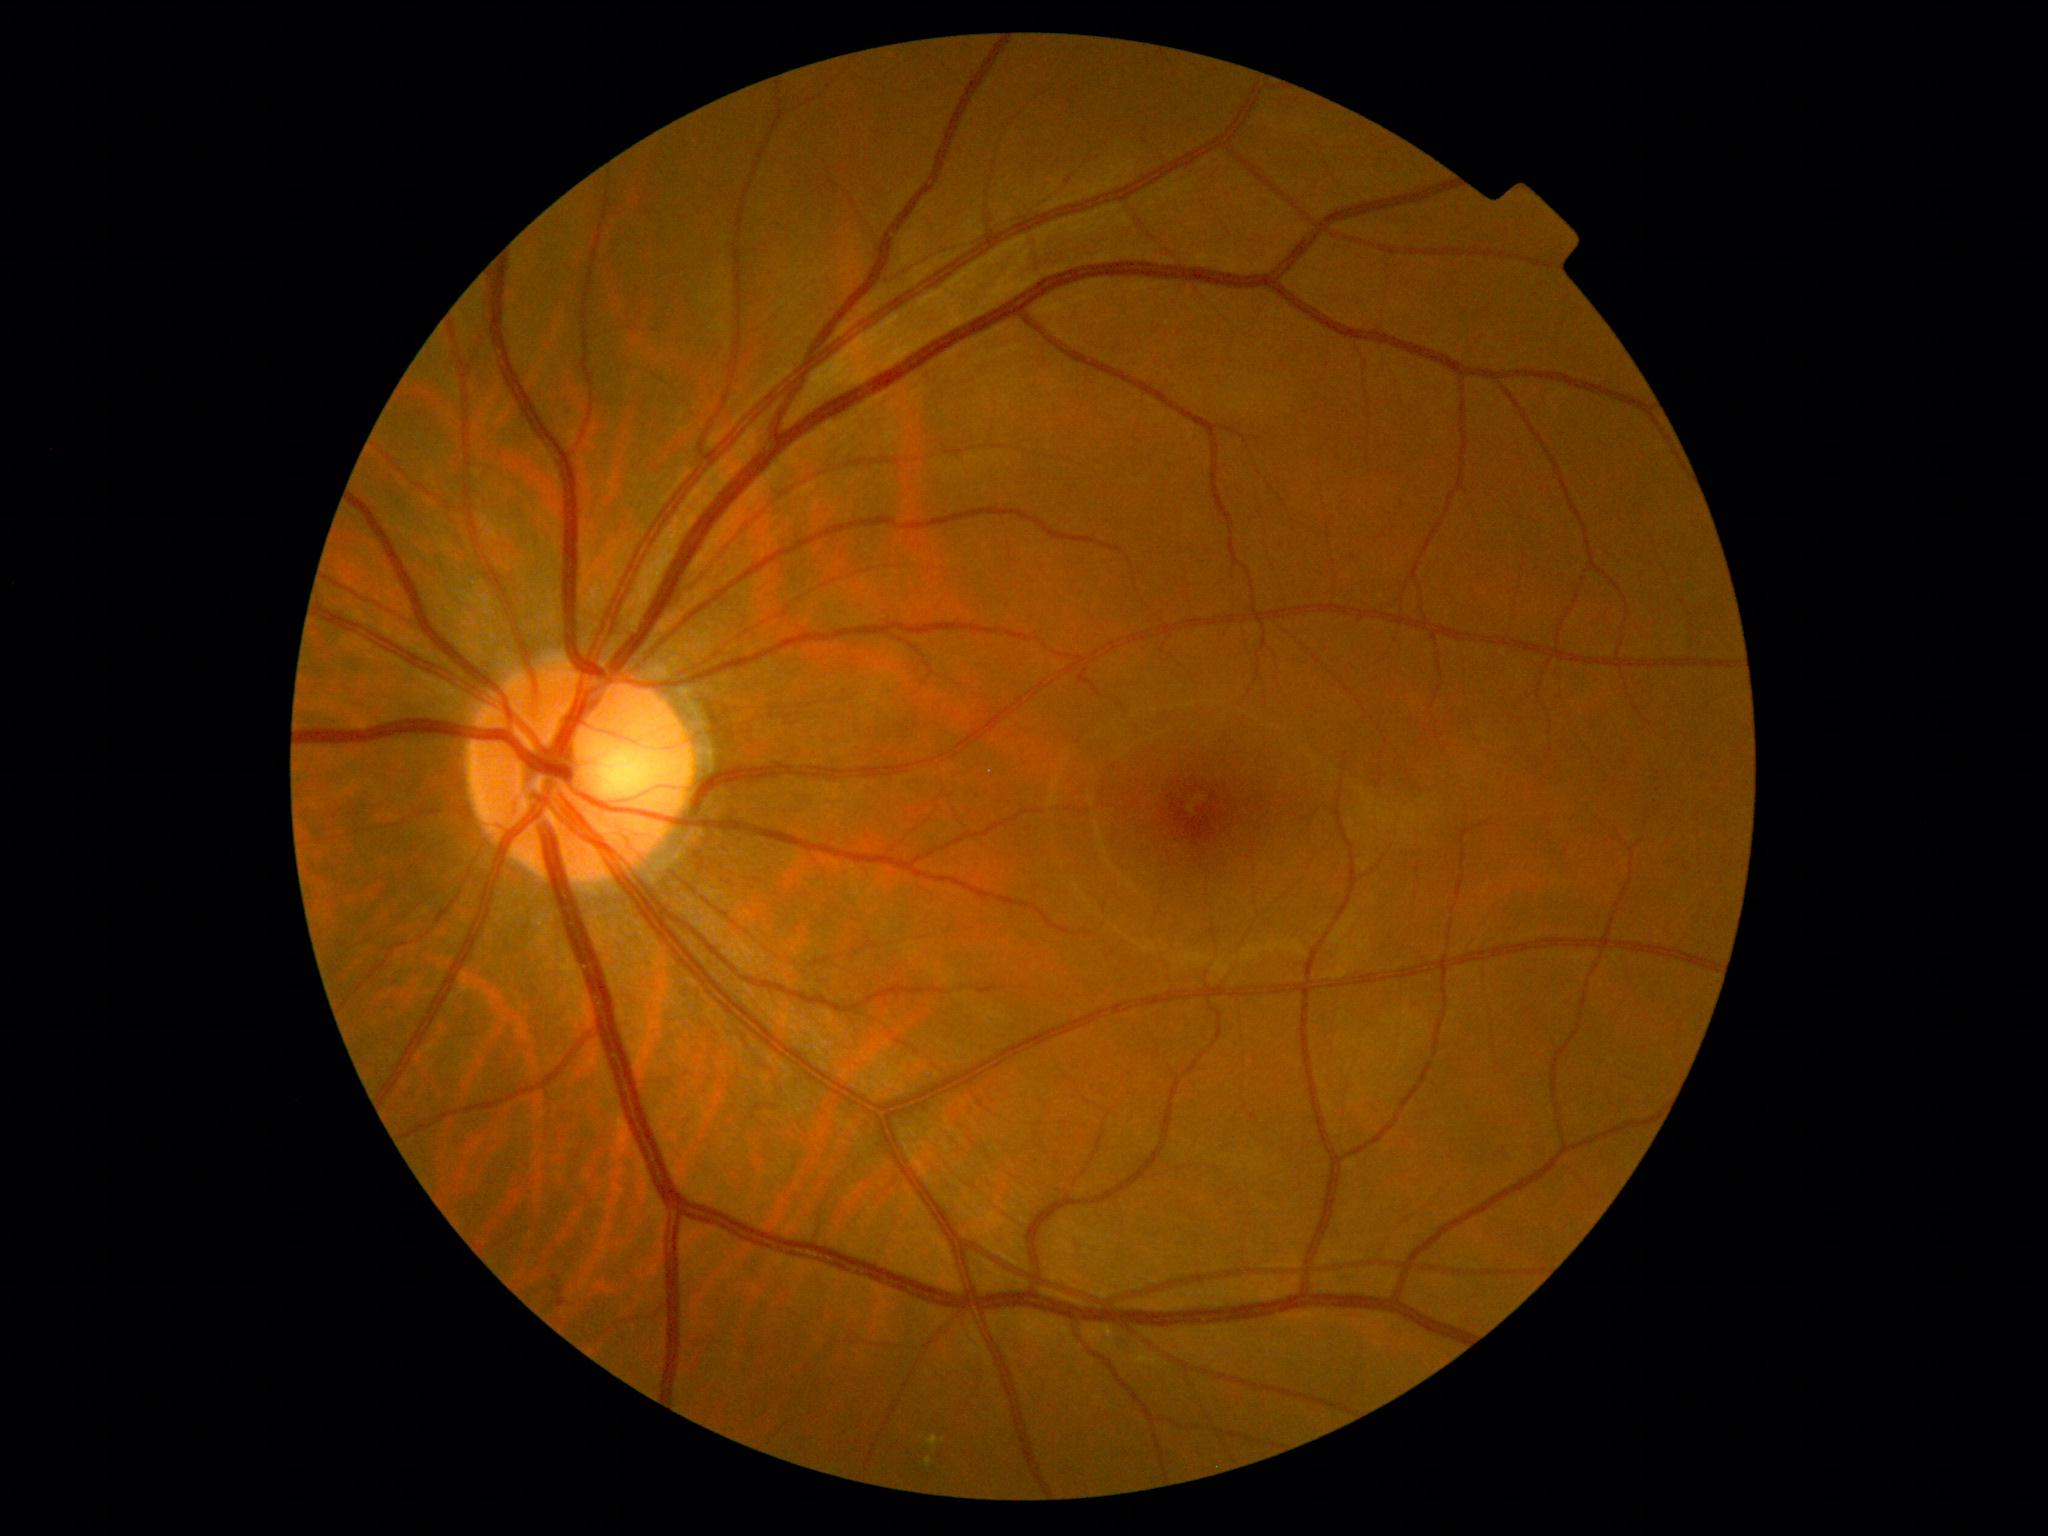 DR: moderate non-proliferative diabetic retinopathy (grade 2).